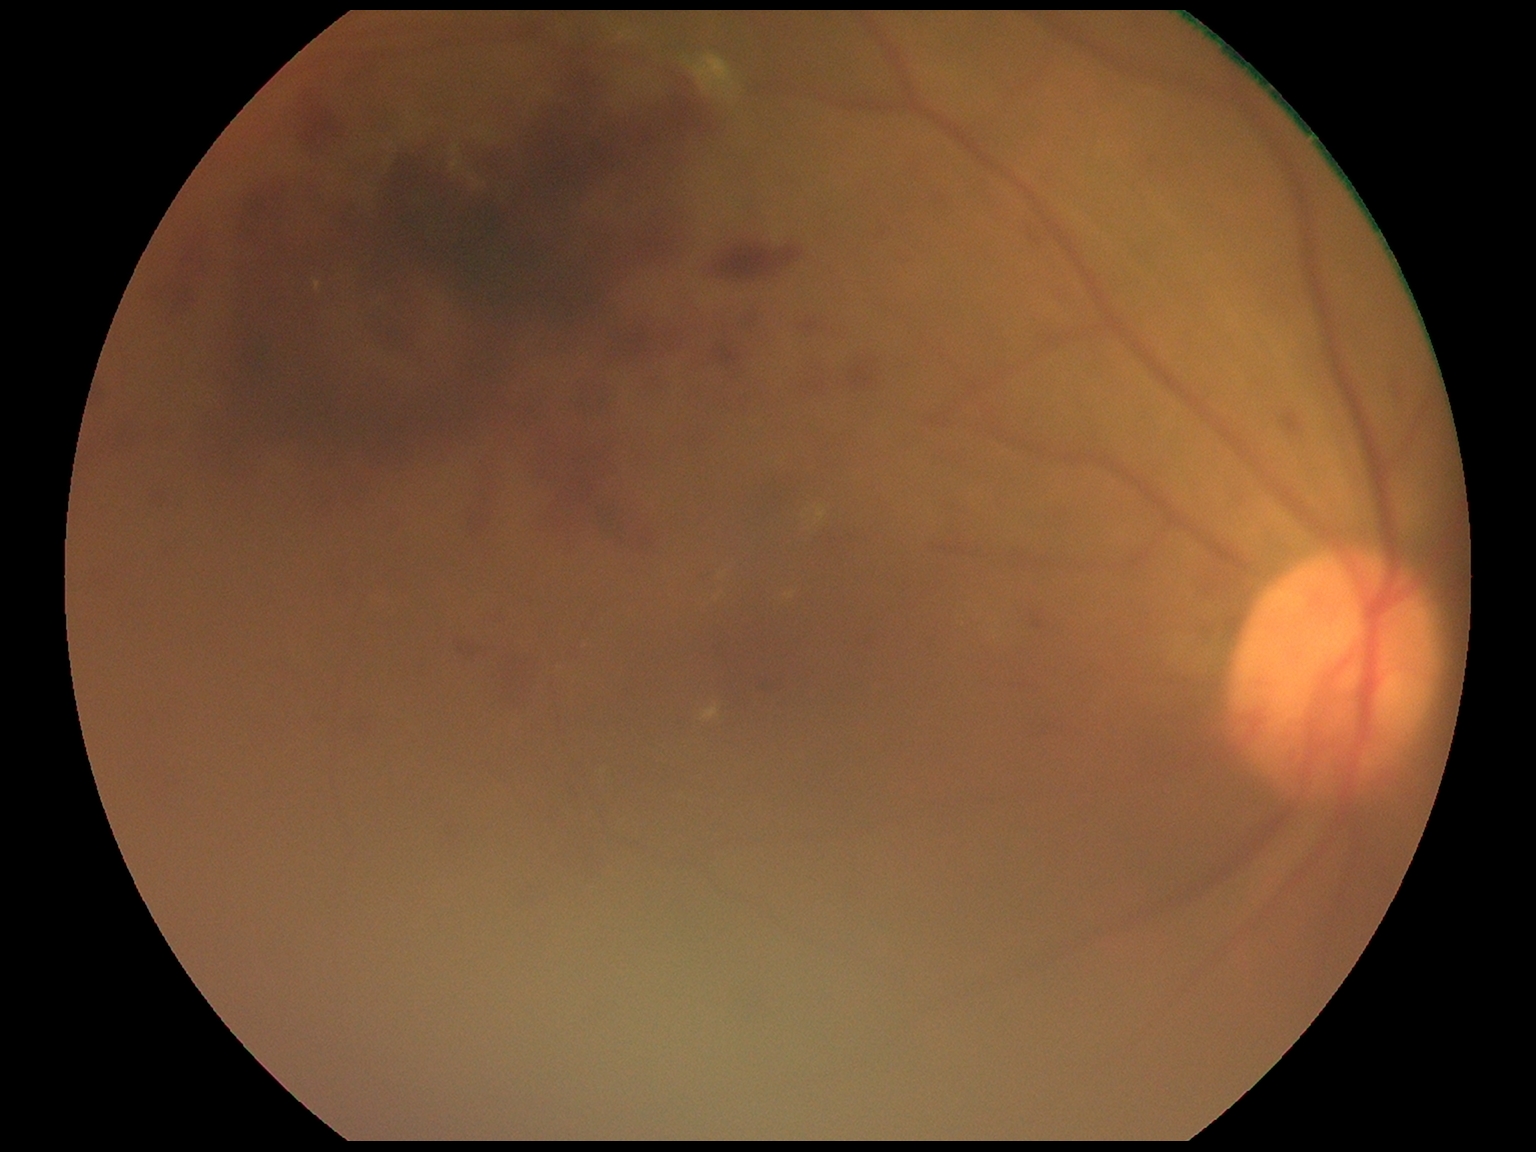

  dr_grade: grade 2 (moderate NPDR)